Infant wide-field retinal image:
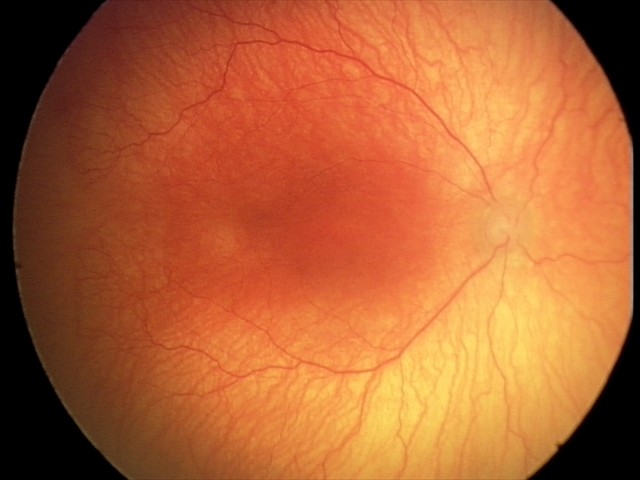 Plus disease present.
From an examination with diagnosis of A-ROP (aggressive ROP) — rapidly progressive severe ROP with prominent plus disease, often without classic stage progression.